45° field of view: 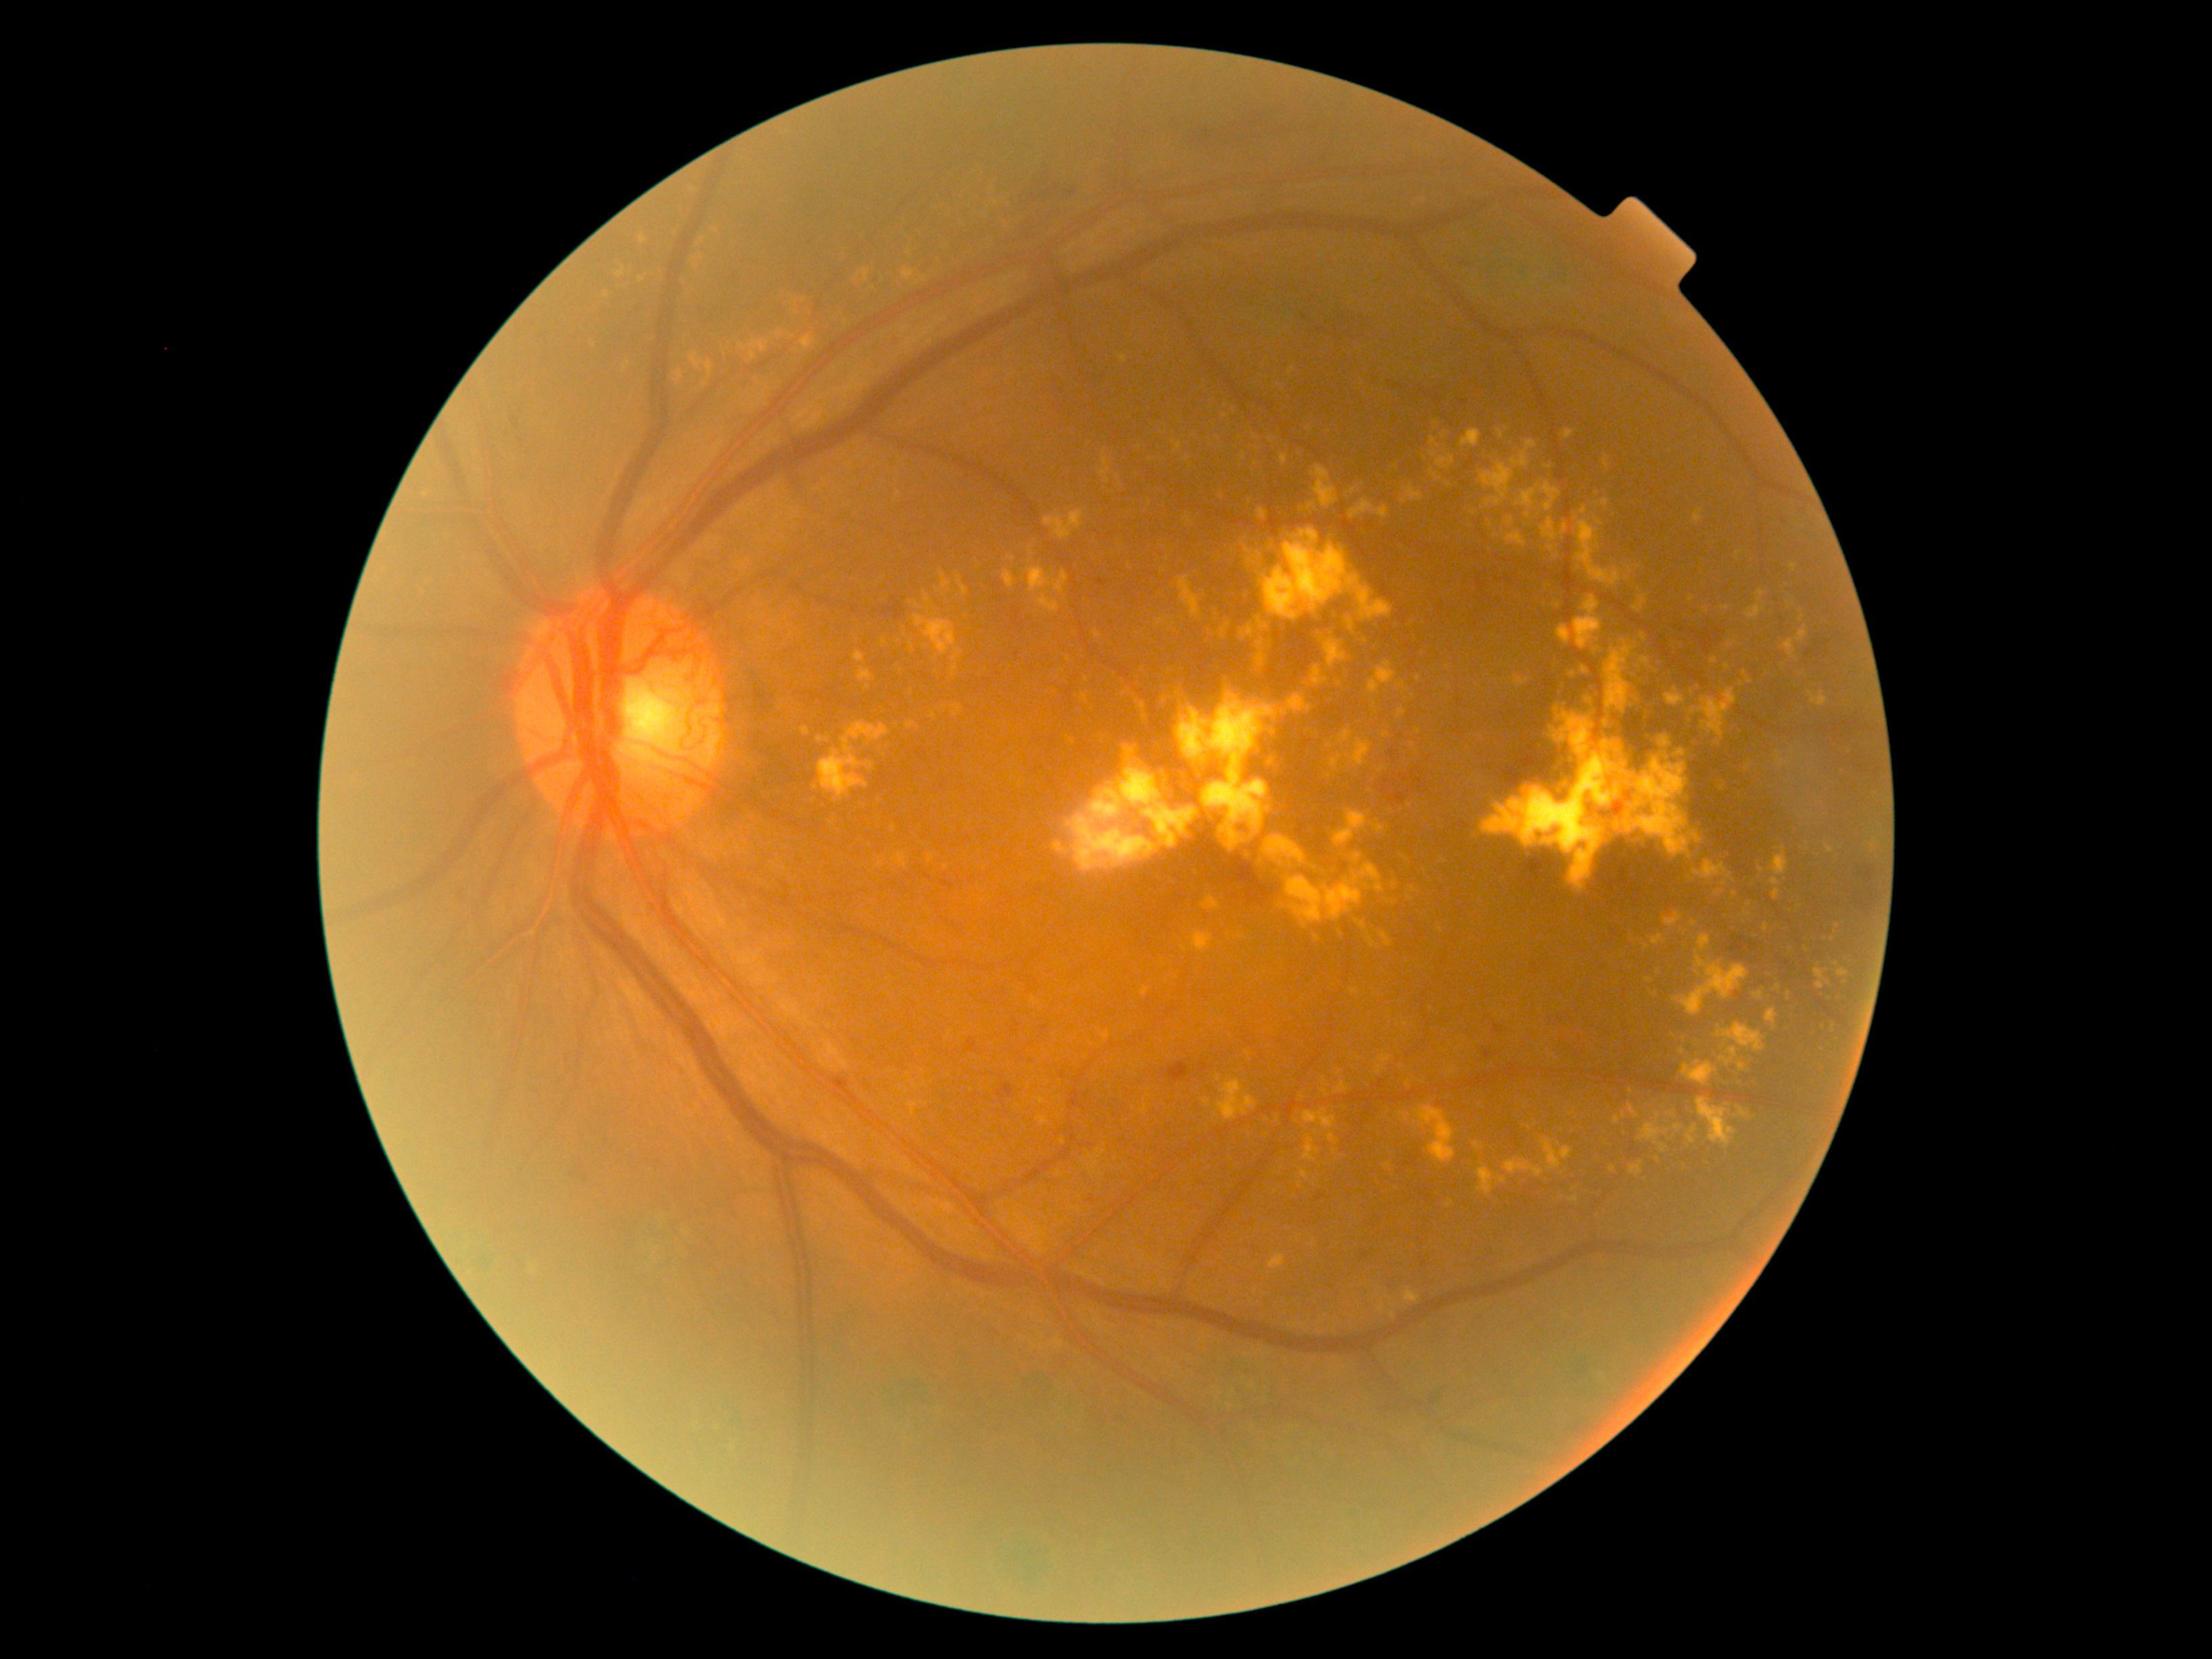 Diabetic retinopathy severity: grade 4 (PDR)
A subset of detected lesions:
hard exudates (subset): [1755,991,1764,1000], [1542,1138,1573,1172], [1576,521,1637,588], [1654,1160,1662,1165], [1054,842,1066,855], [1376,1055,1391,1074], [1711,657,1718,665], [1352,853,1363,864], [1265,760,1275,766], [1639,1122,1662,1142], [1721,1057,1730,1066], [1219,623,1231,640]
Small hard exudates approximately at (1168, 557), (1261, 622), (1556, 606), (1691, 599), (1572, 674), (1324, 1080), (1013, 560), (1624, 1116)